Graded on the modified Davis scale — 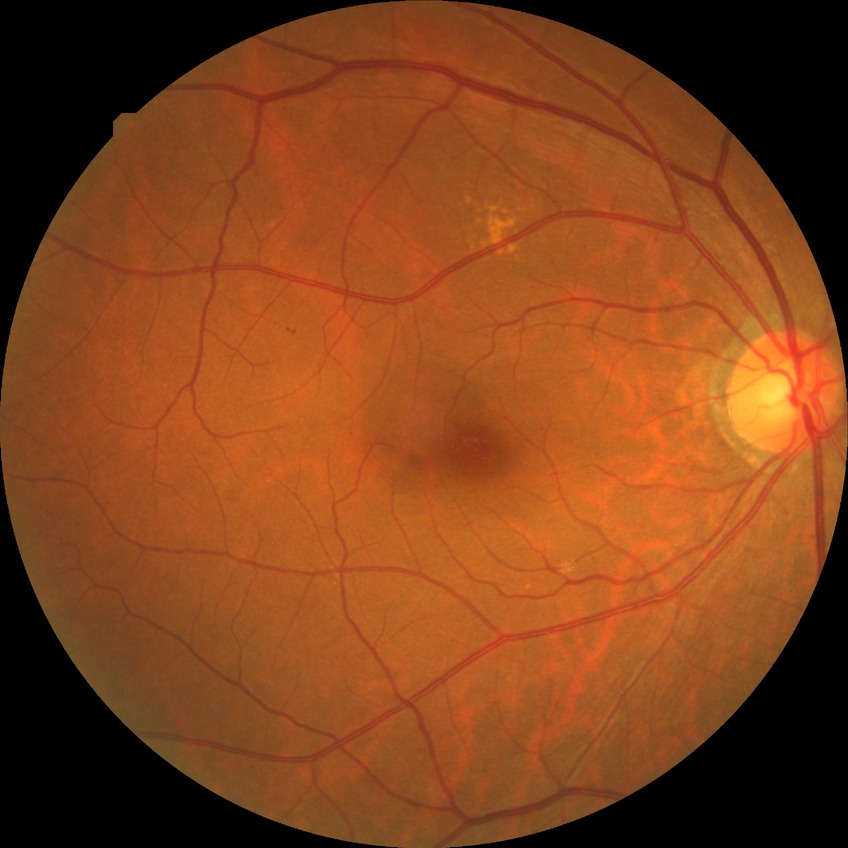
DR class: non-proliferative diabetic retinopathy. Diabetic retinopathy (DR) is simple diabetic retinopathy (SDR).